Infant wide-field retinal image: 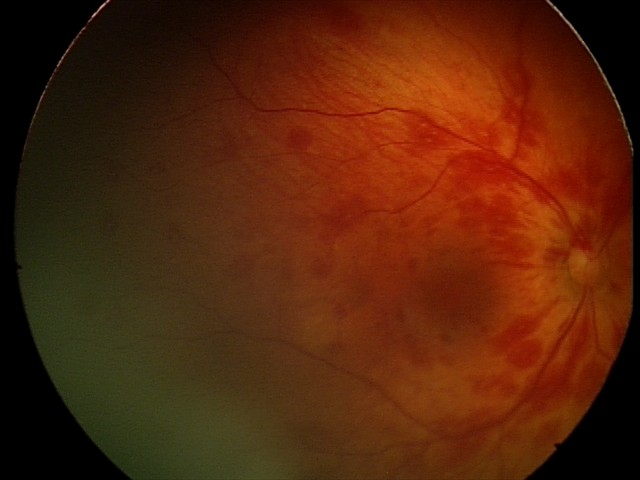
Screening examination consistent with retinal hemorrhages.